Color fundus photograph from a handheld portable camera:
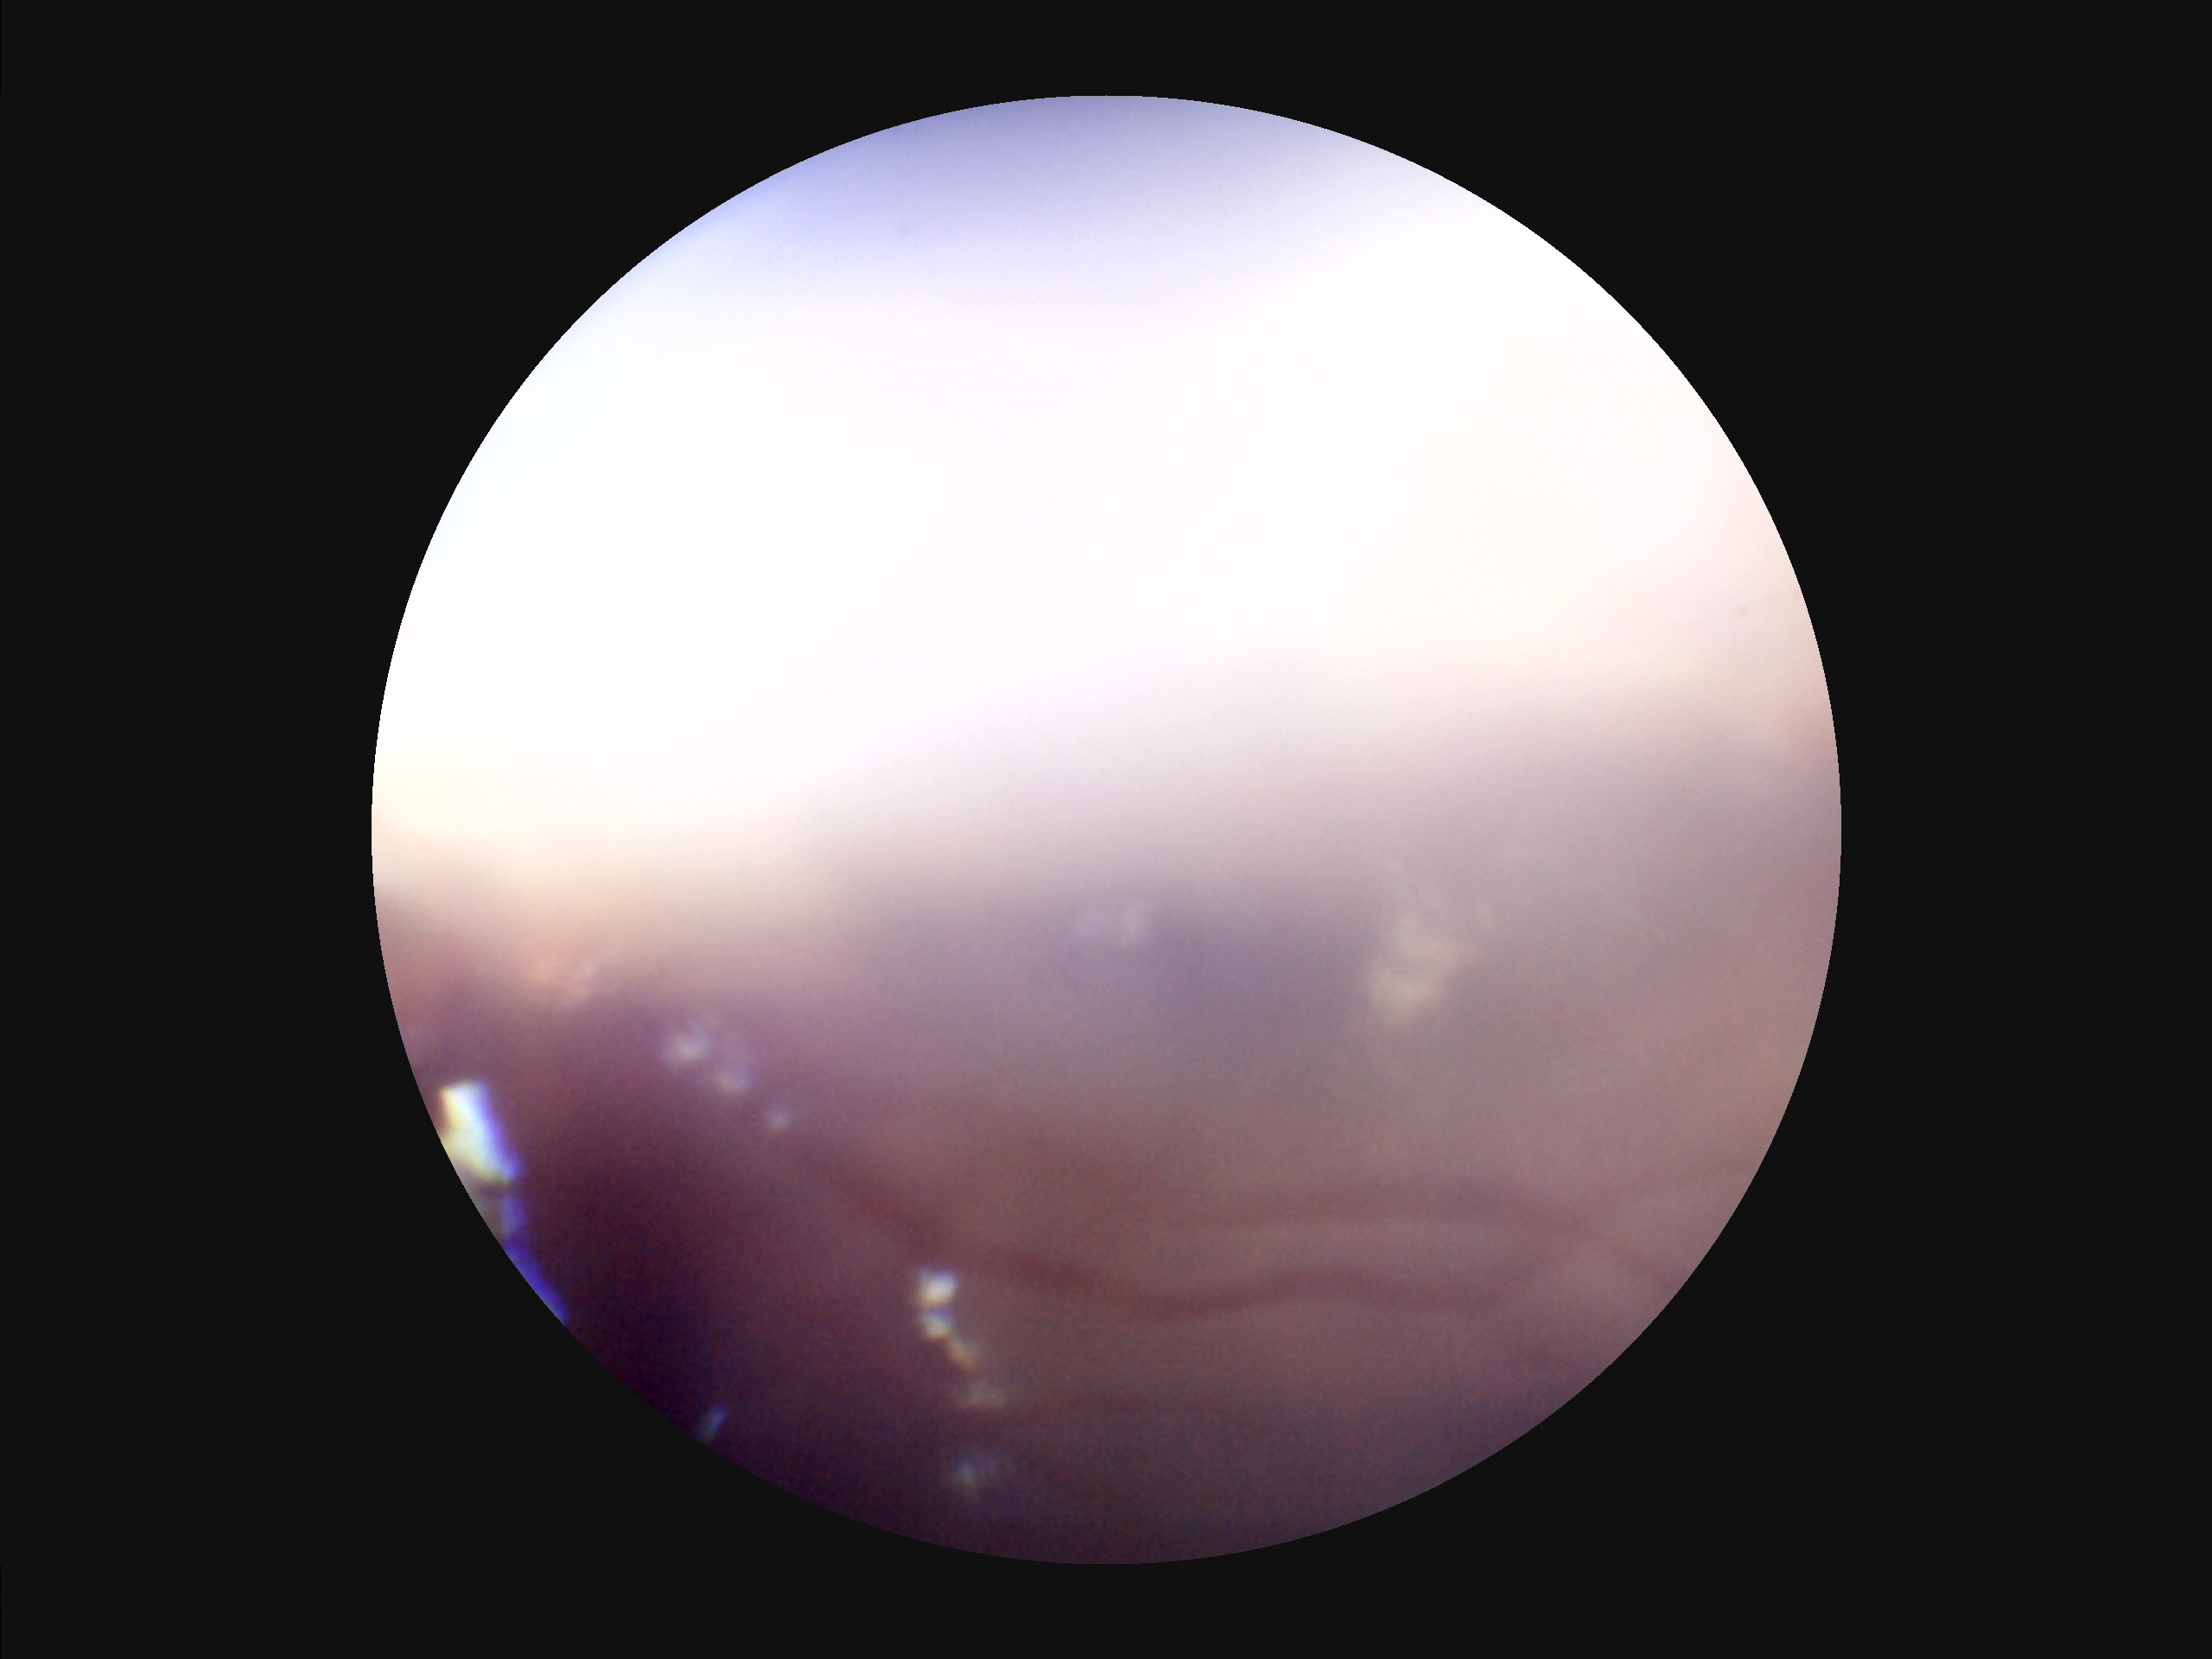 There is over- or under-exposure or a color cast. Out of focus; structures are indistinct. Narrow intensity range; structures are hard to distinguish. Image quality is suboptimal.